Wide-field fundus photograph of an infant · 100° field of view (Phoenix ICON)
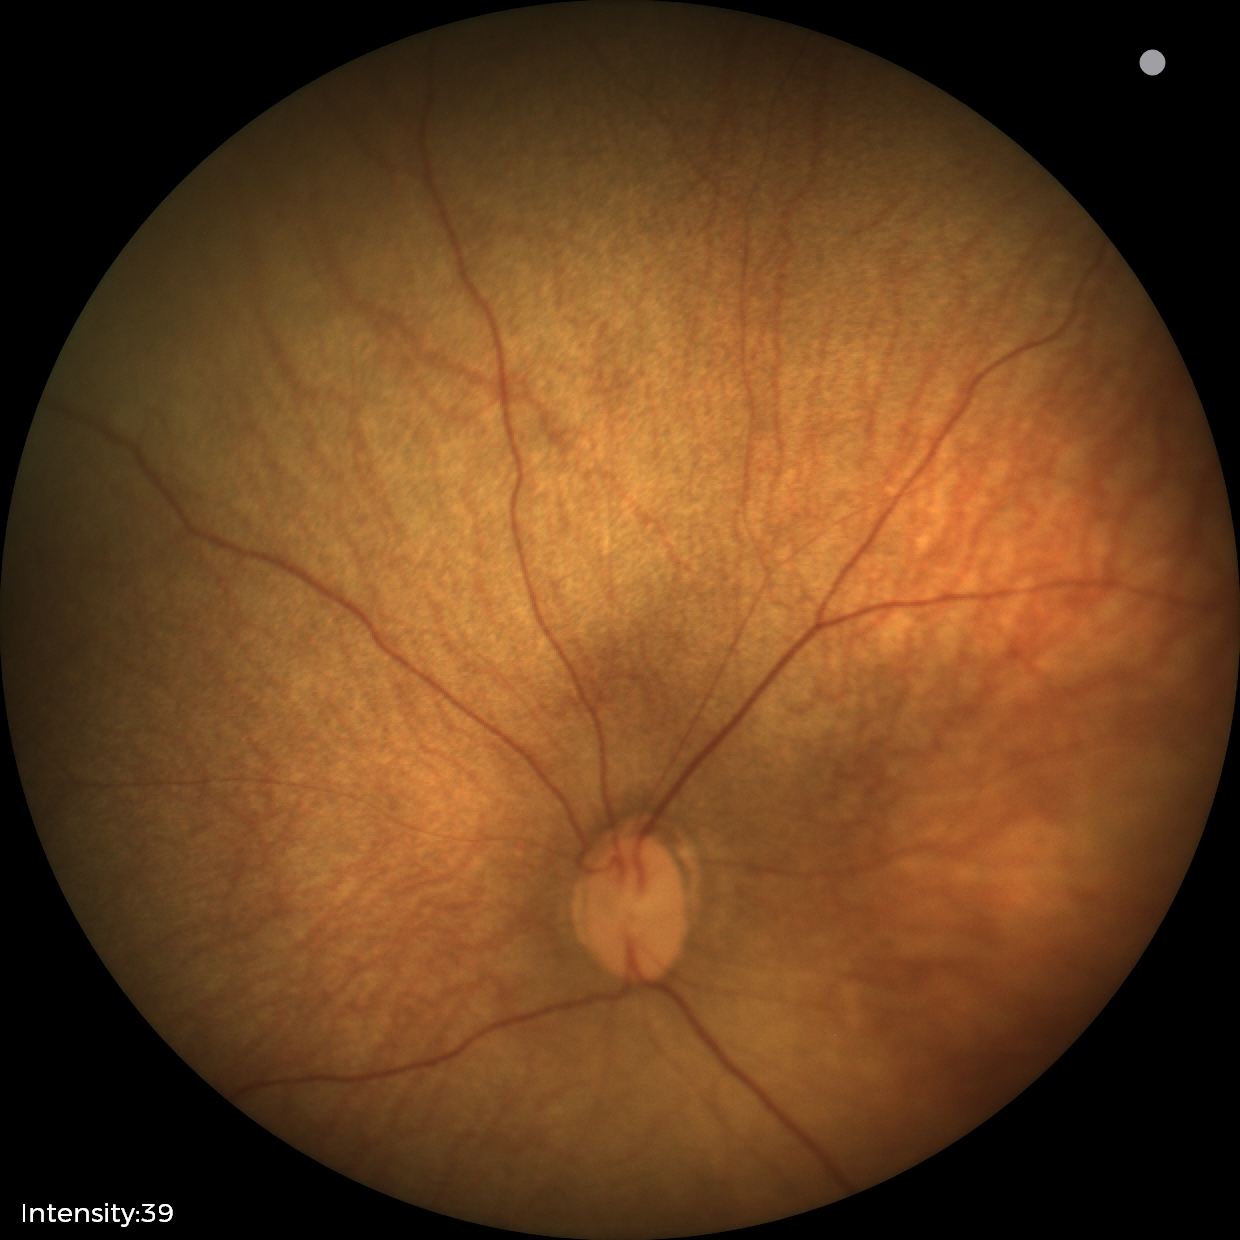 No retinal pathology identified on screening.